Captured on a Topcon TRC-50DX fundus camera
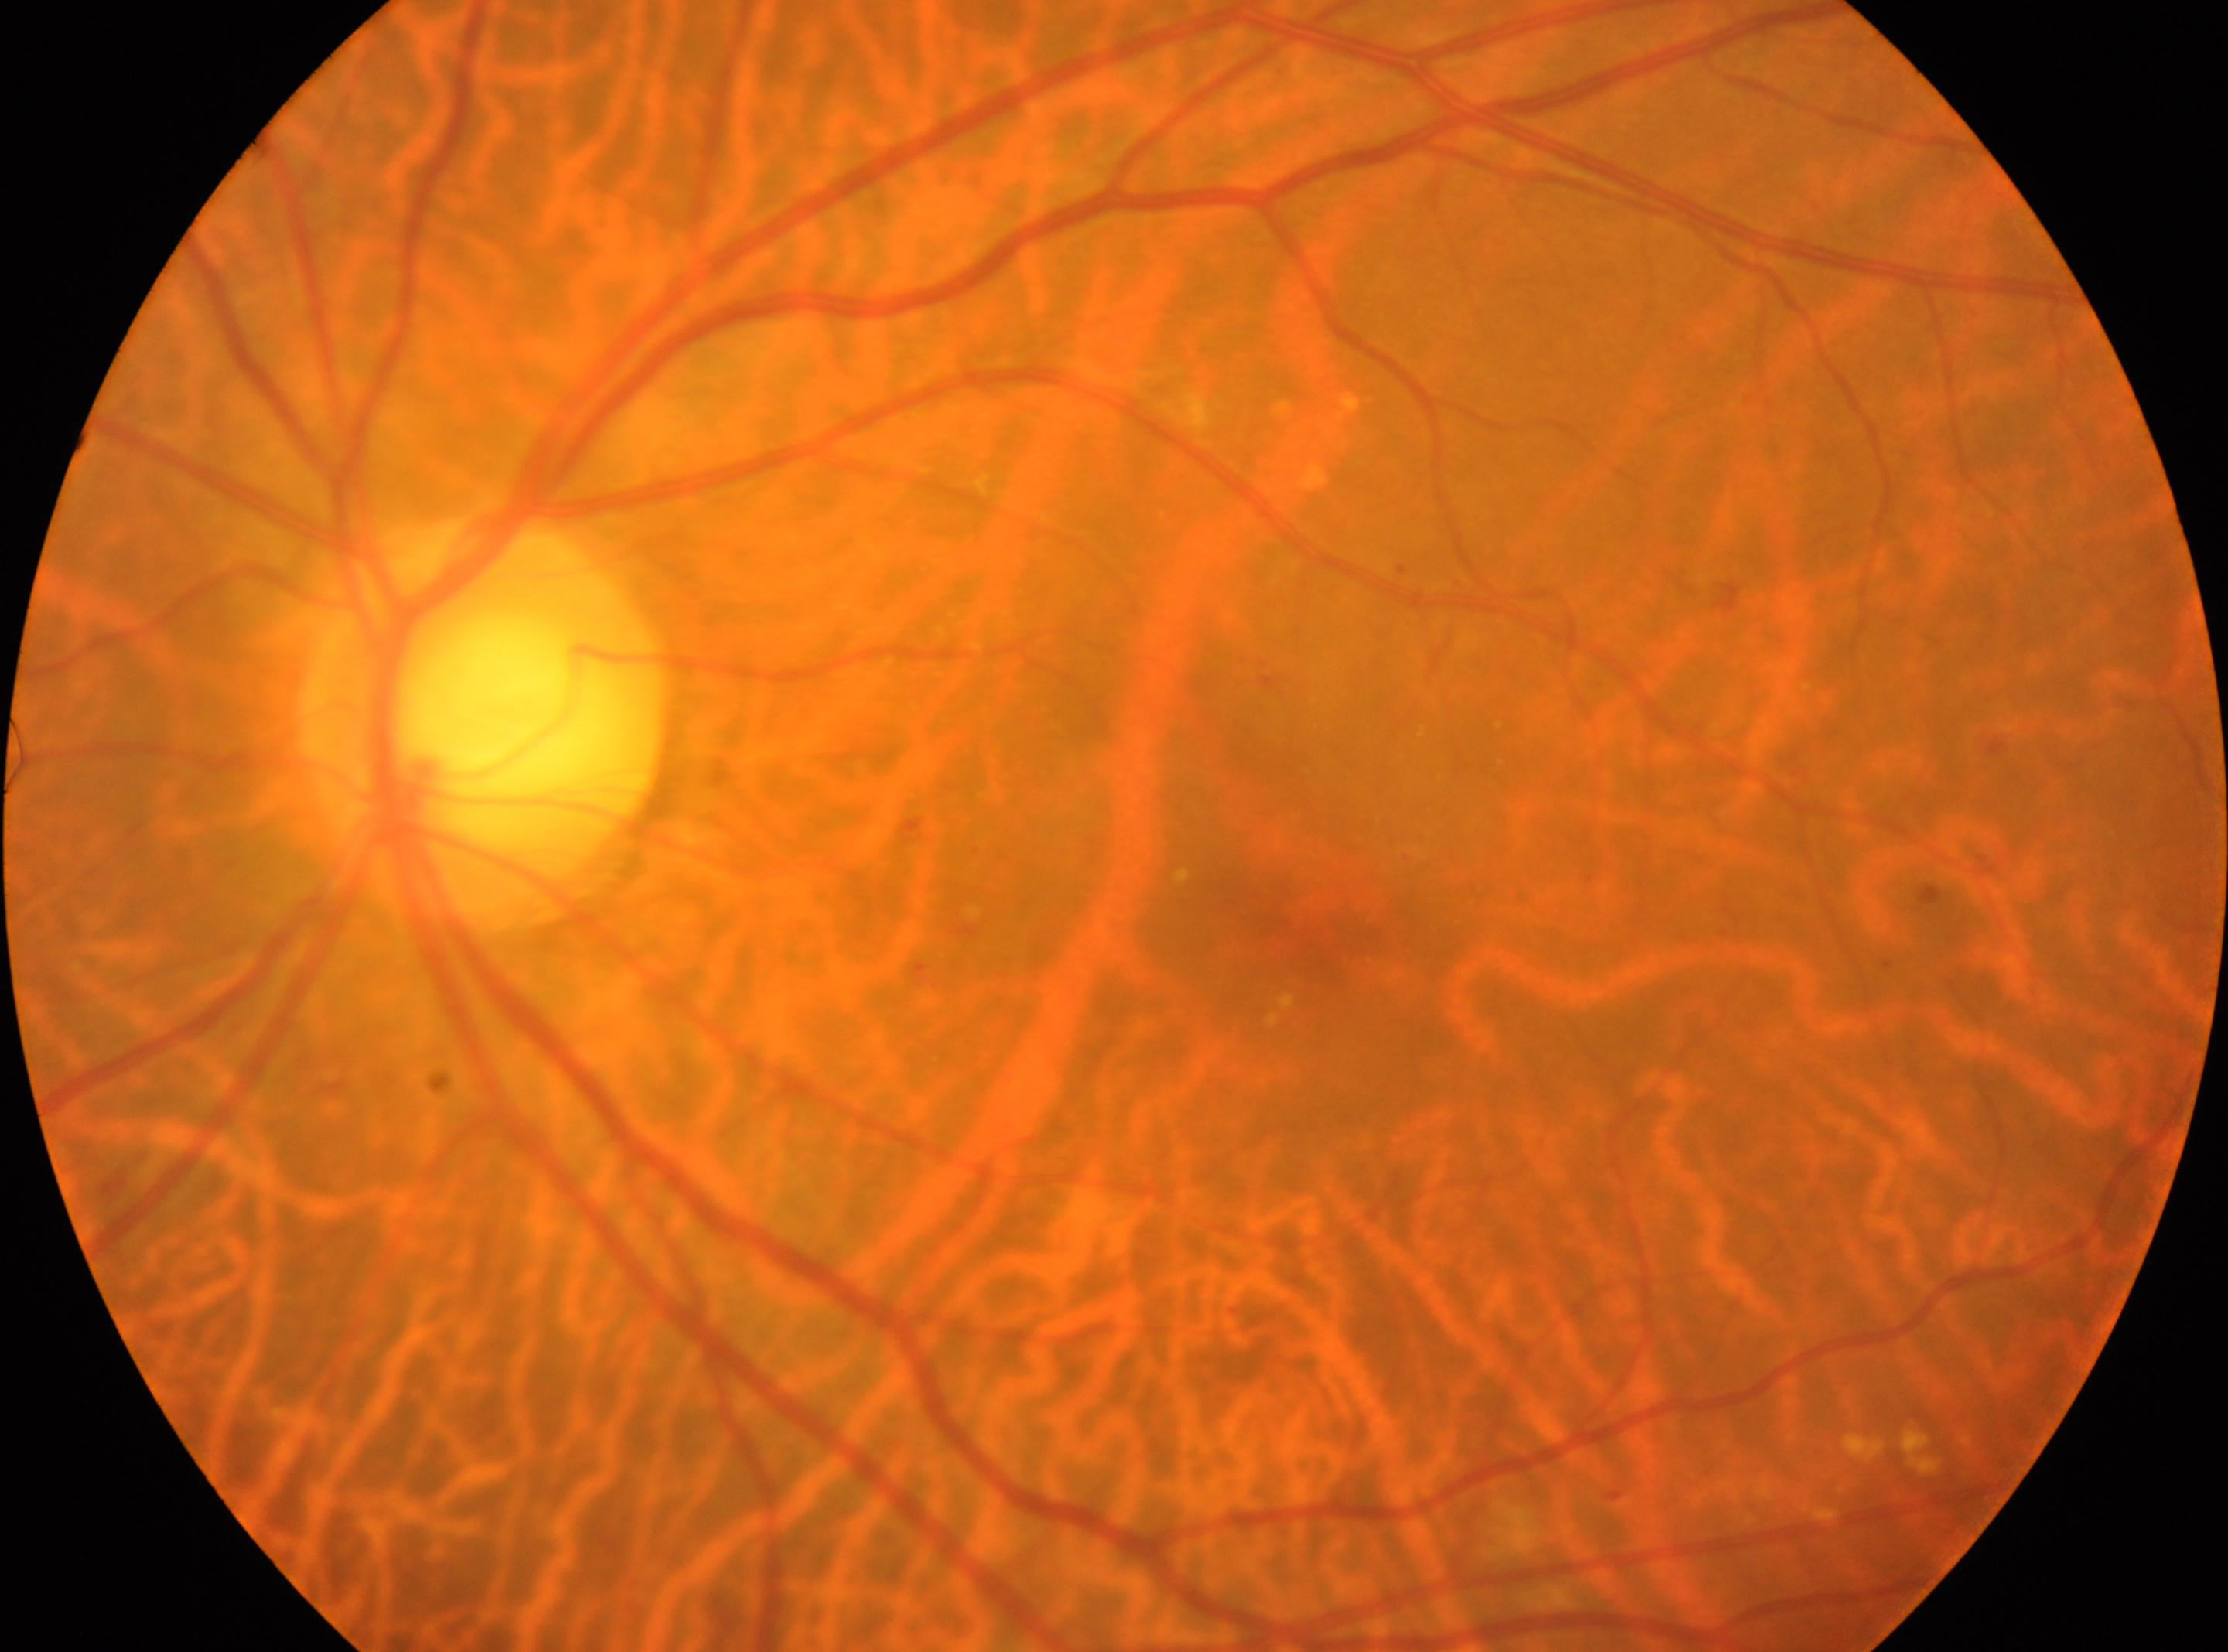 DR stage: 2 | laterality: the left eye | optic disc: (484, 712) | the fovea: (1315, 936).